Fundus photo. FOV: 50 degrees.
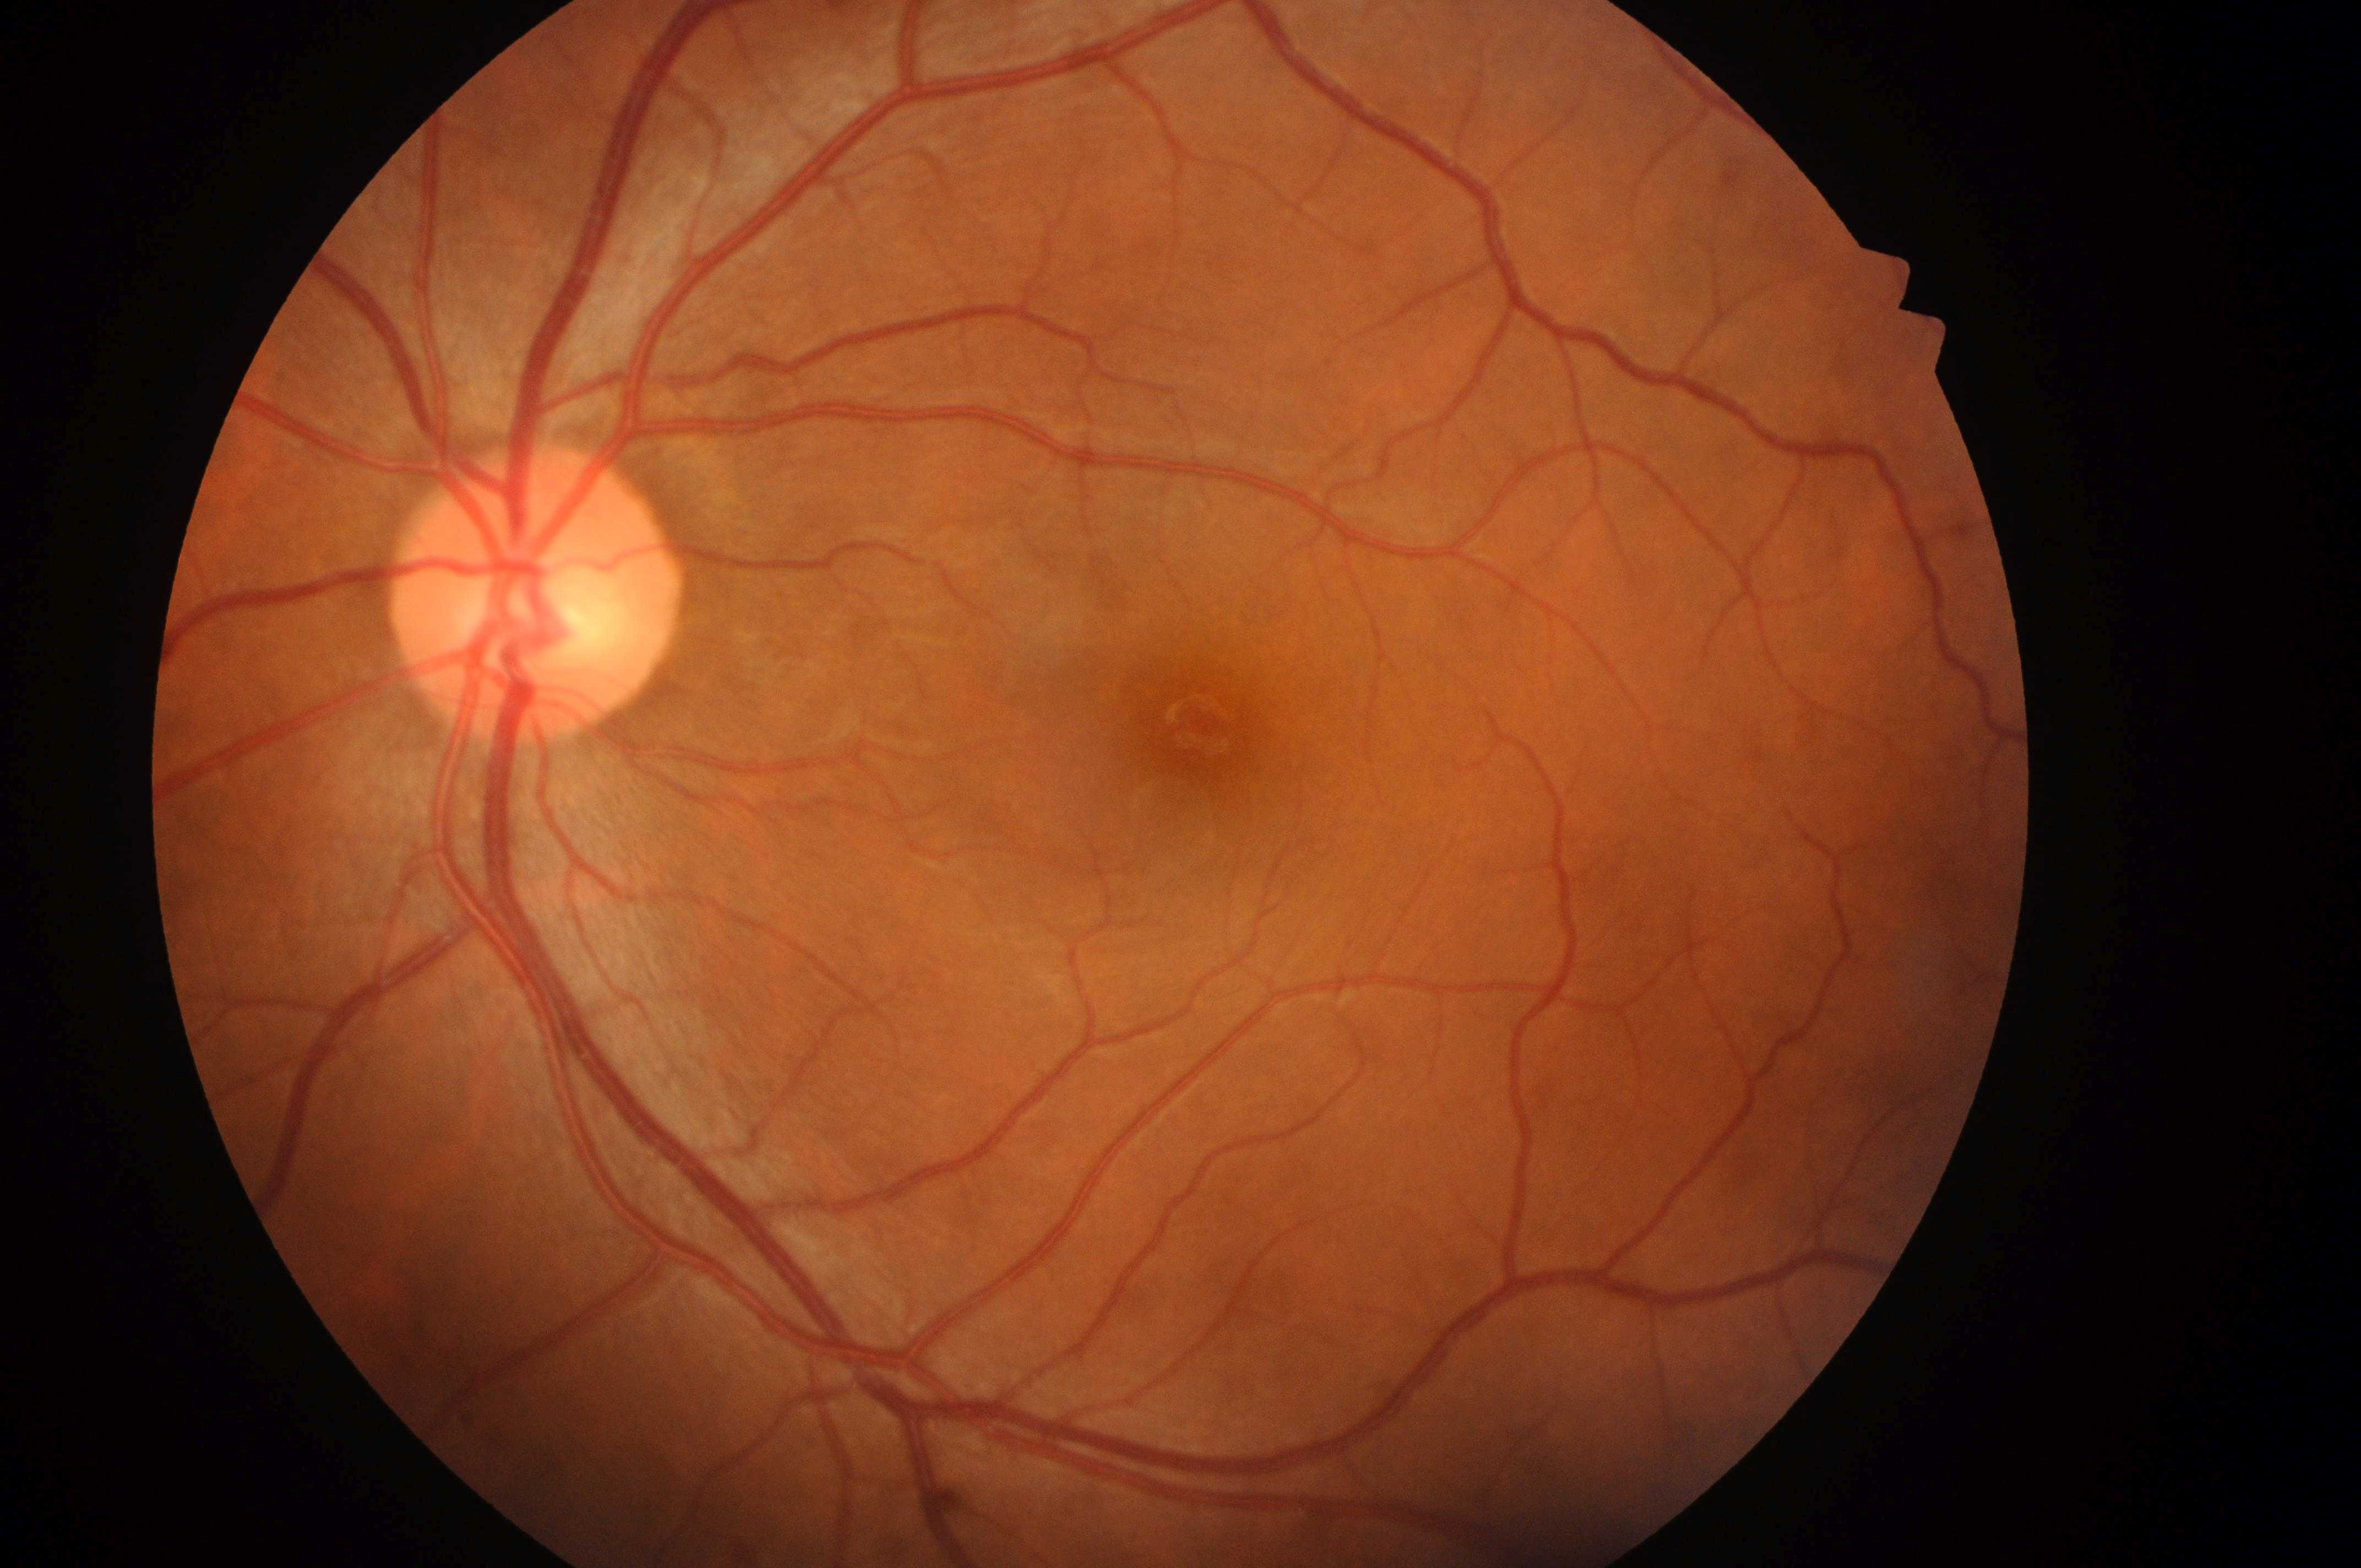 Annotations:
- DR severity: no apparent diabetic retinopathy (grade 0)
- macular center: (1205,727)
- DME risk: no risk (grade 0)
- ONH: (530,604)
- laterality: left